CFP; 2352x1568 — 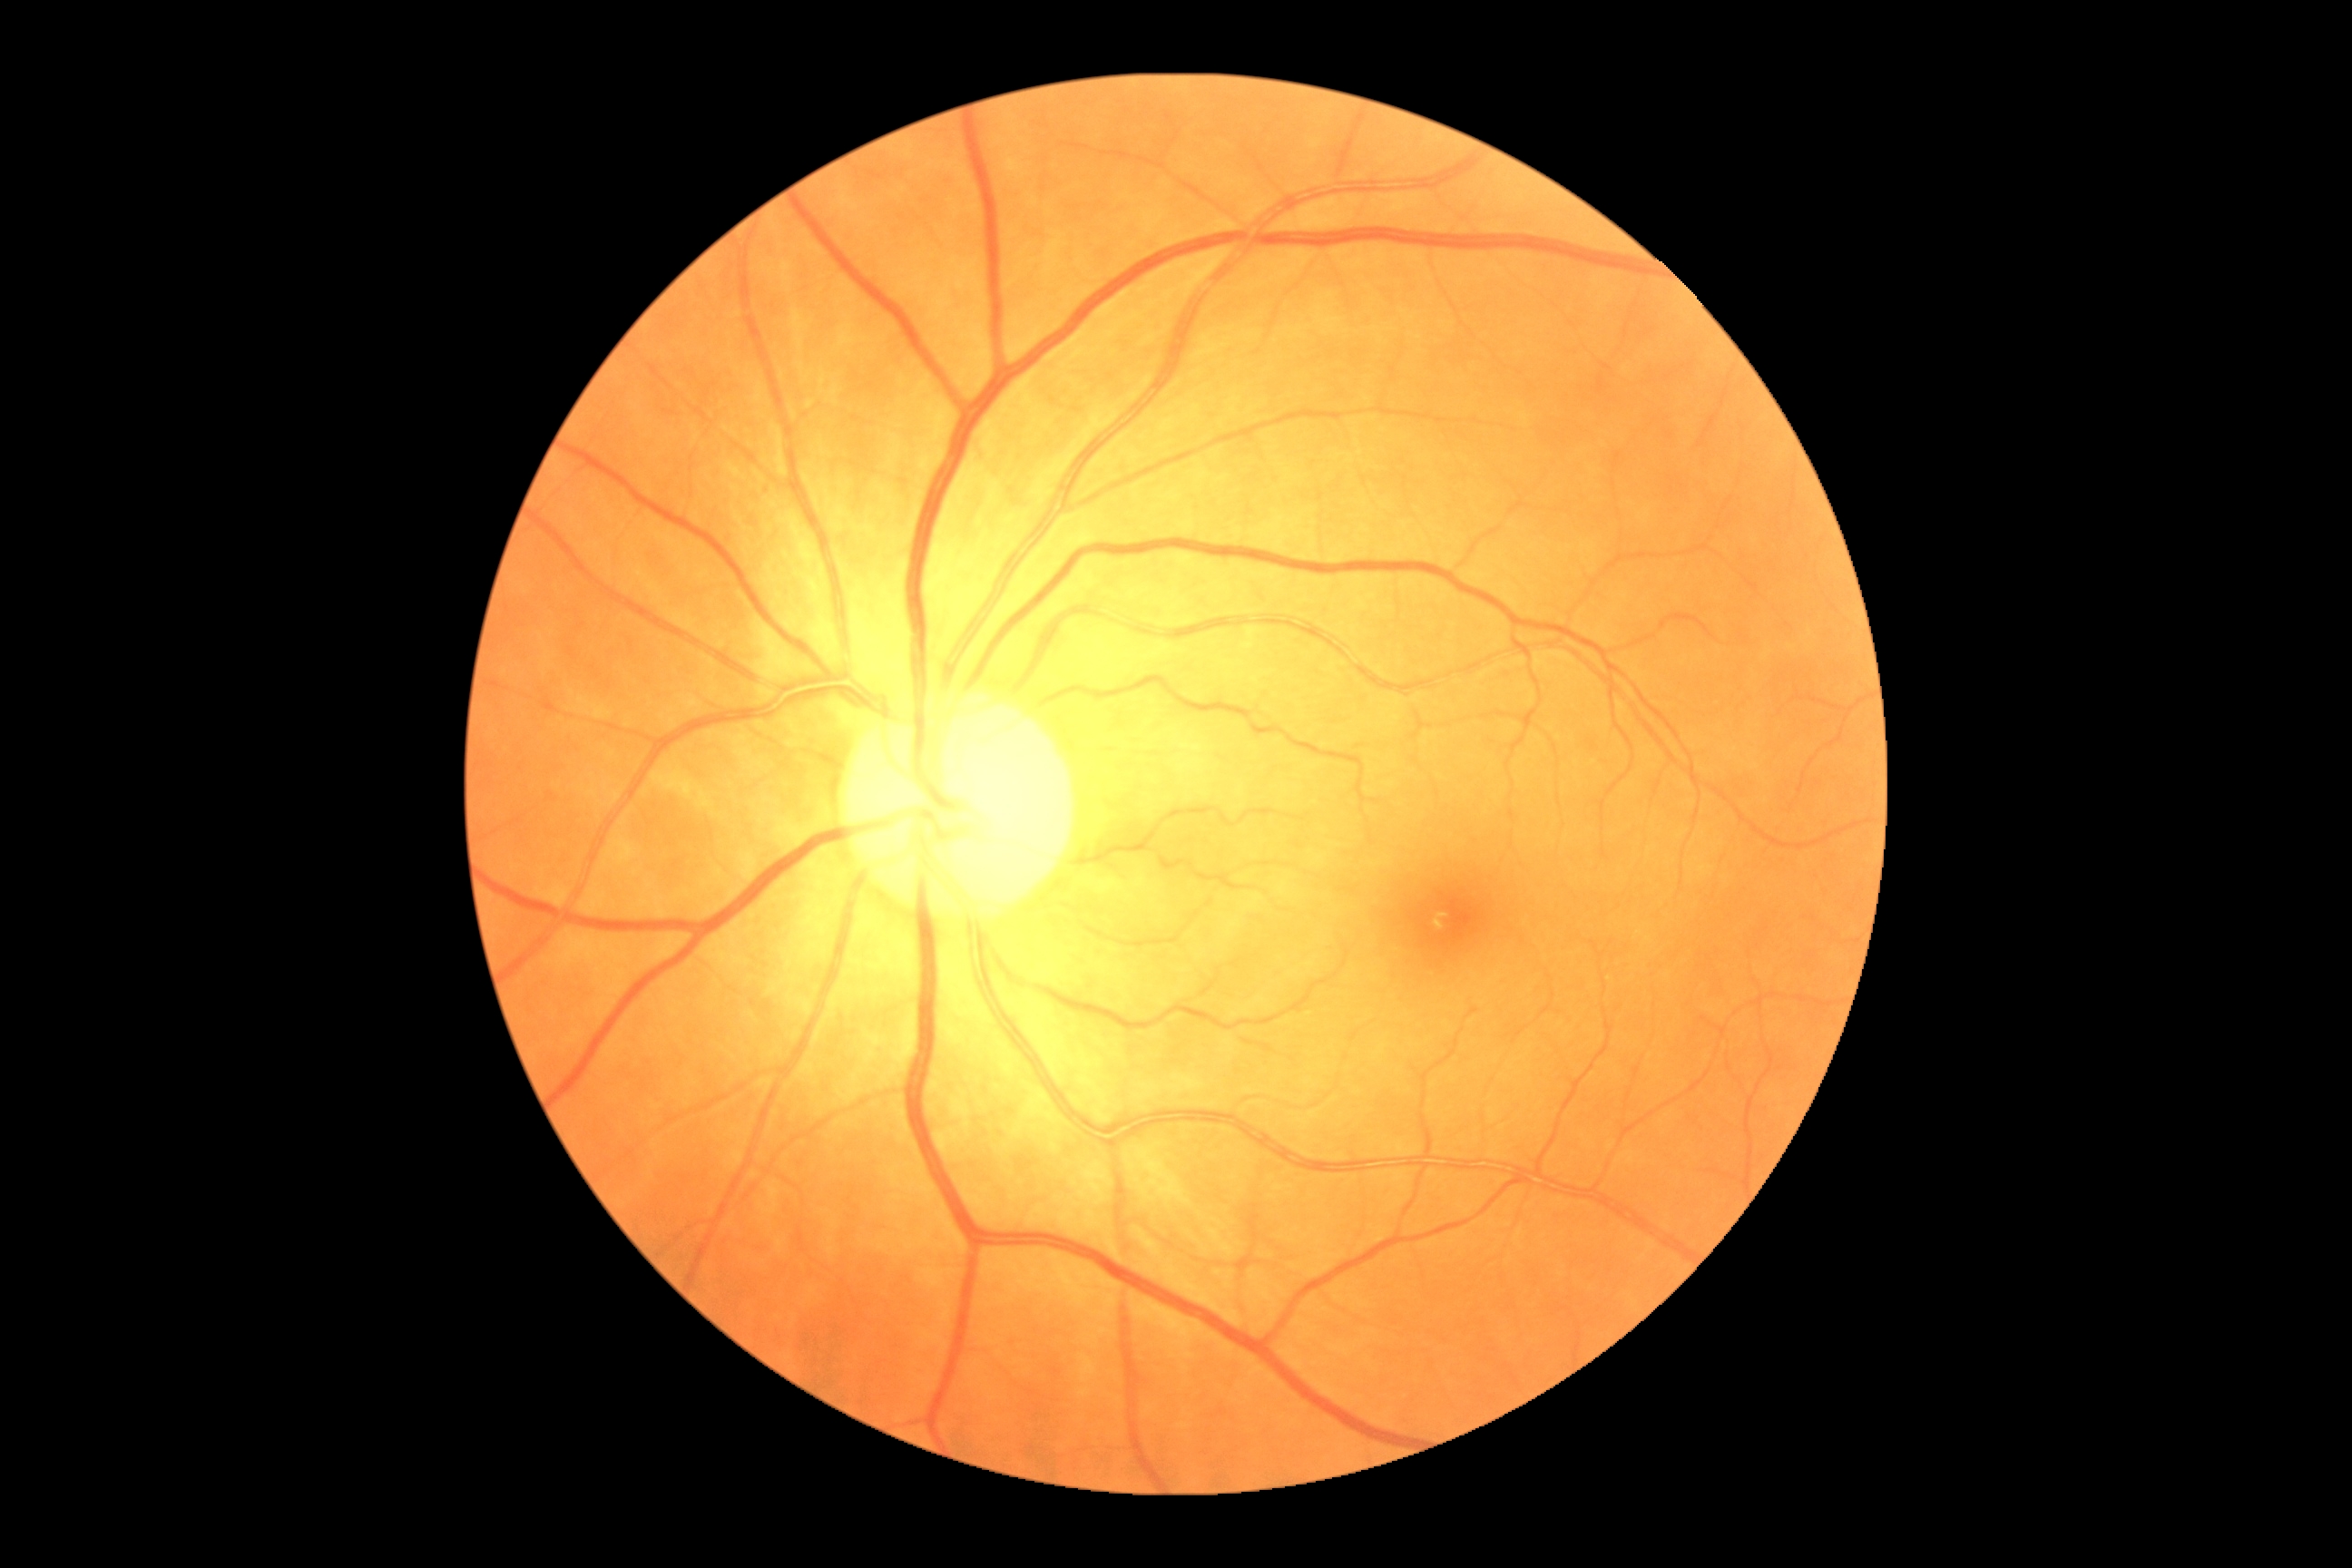
diabetic retinopathy = 0.